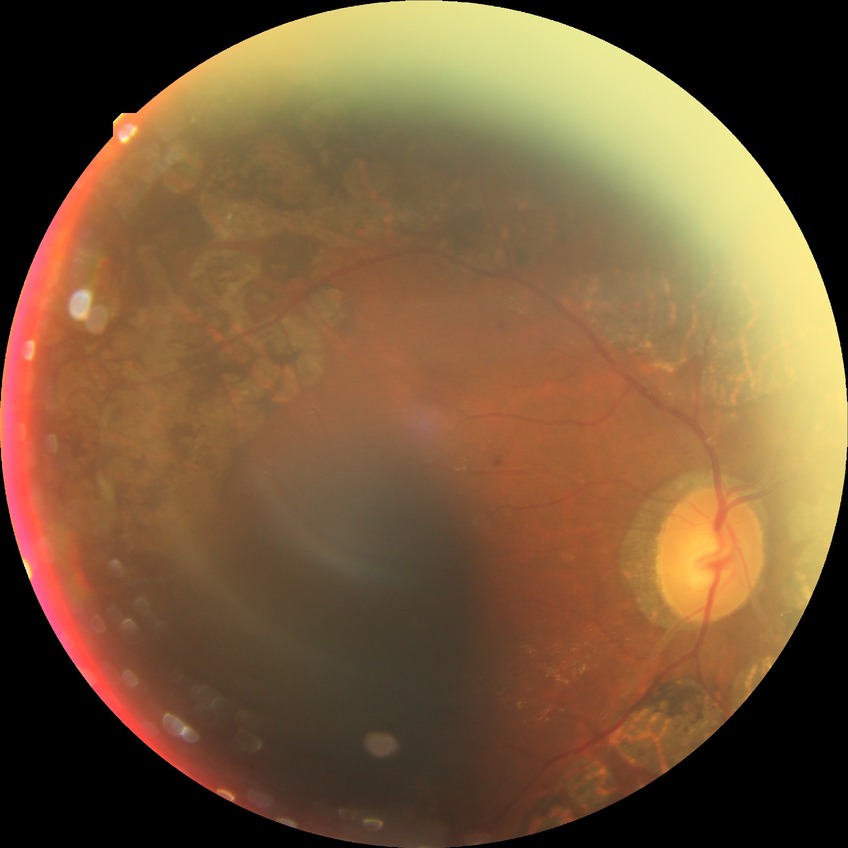 DR stage: PDR.